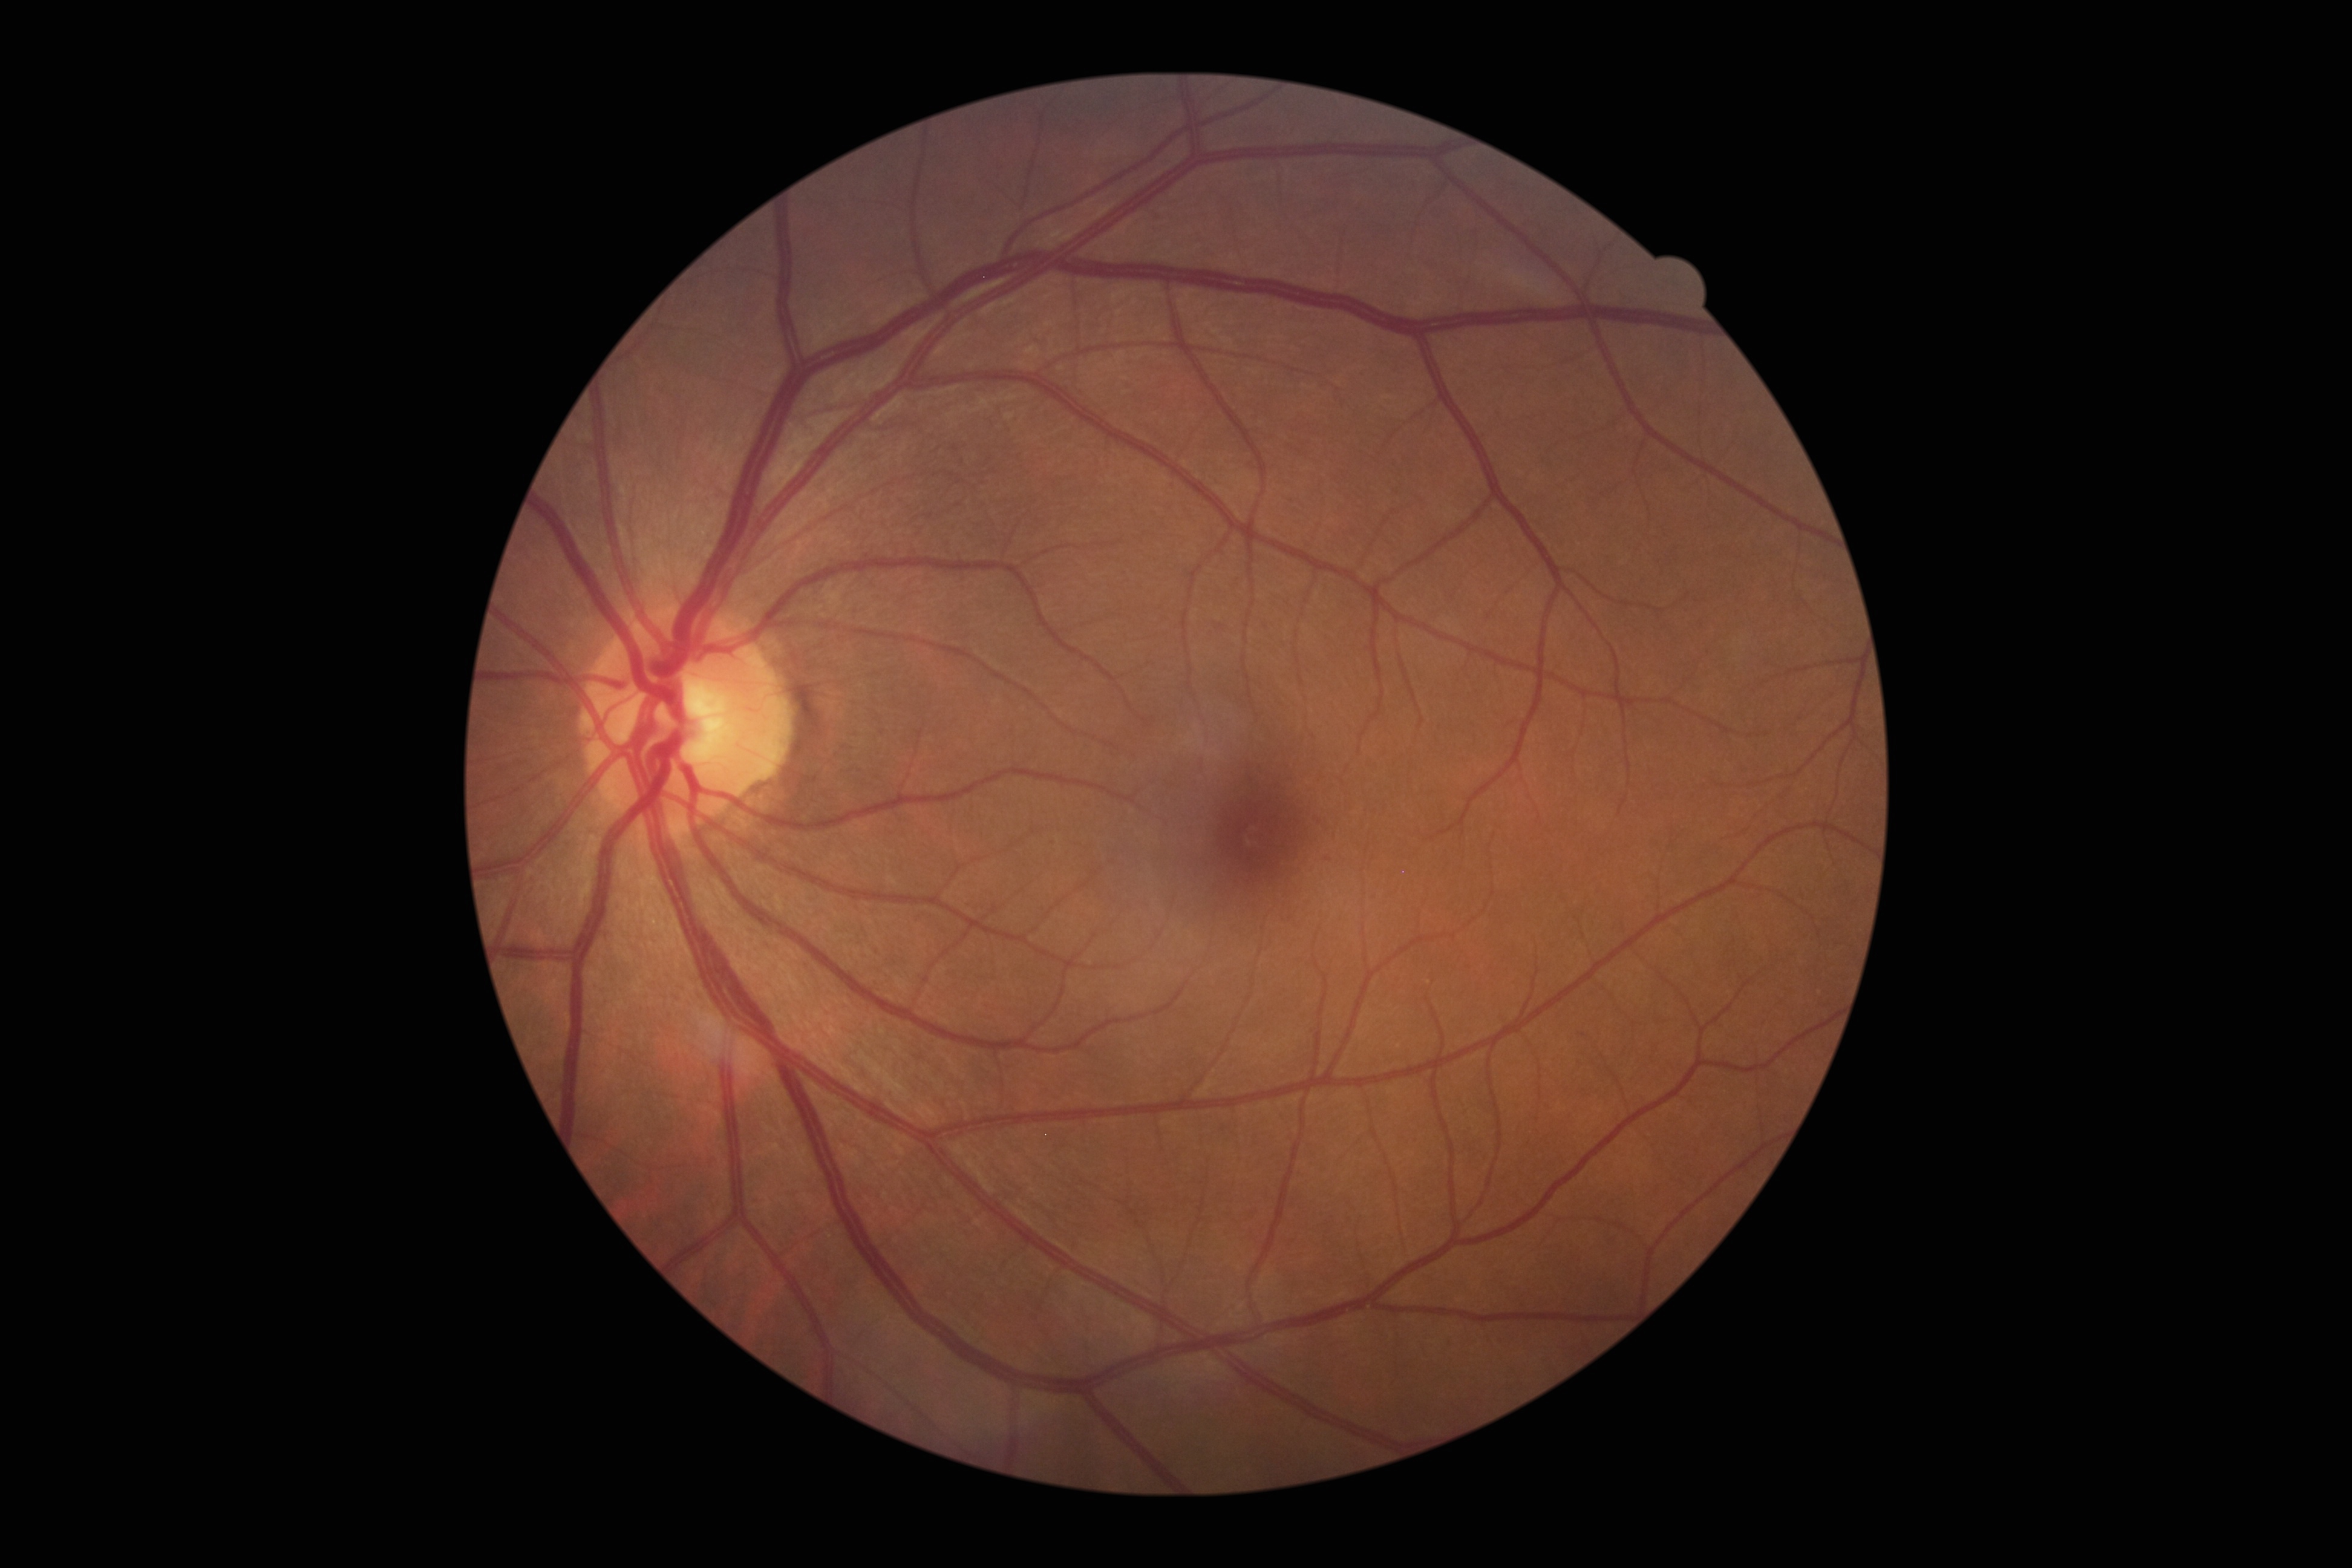
DR class: non-proliferative diabetic retinopathy; DR severity: mild NPDR (grade 1).